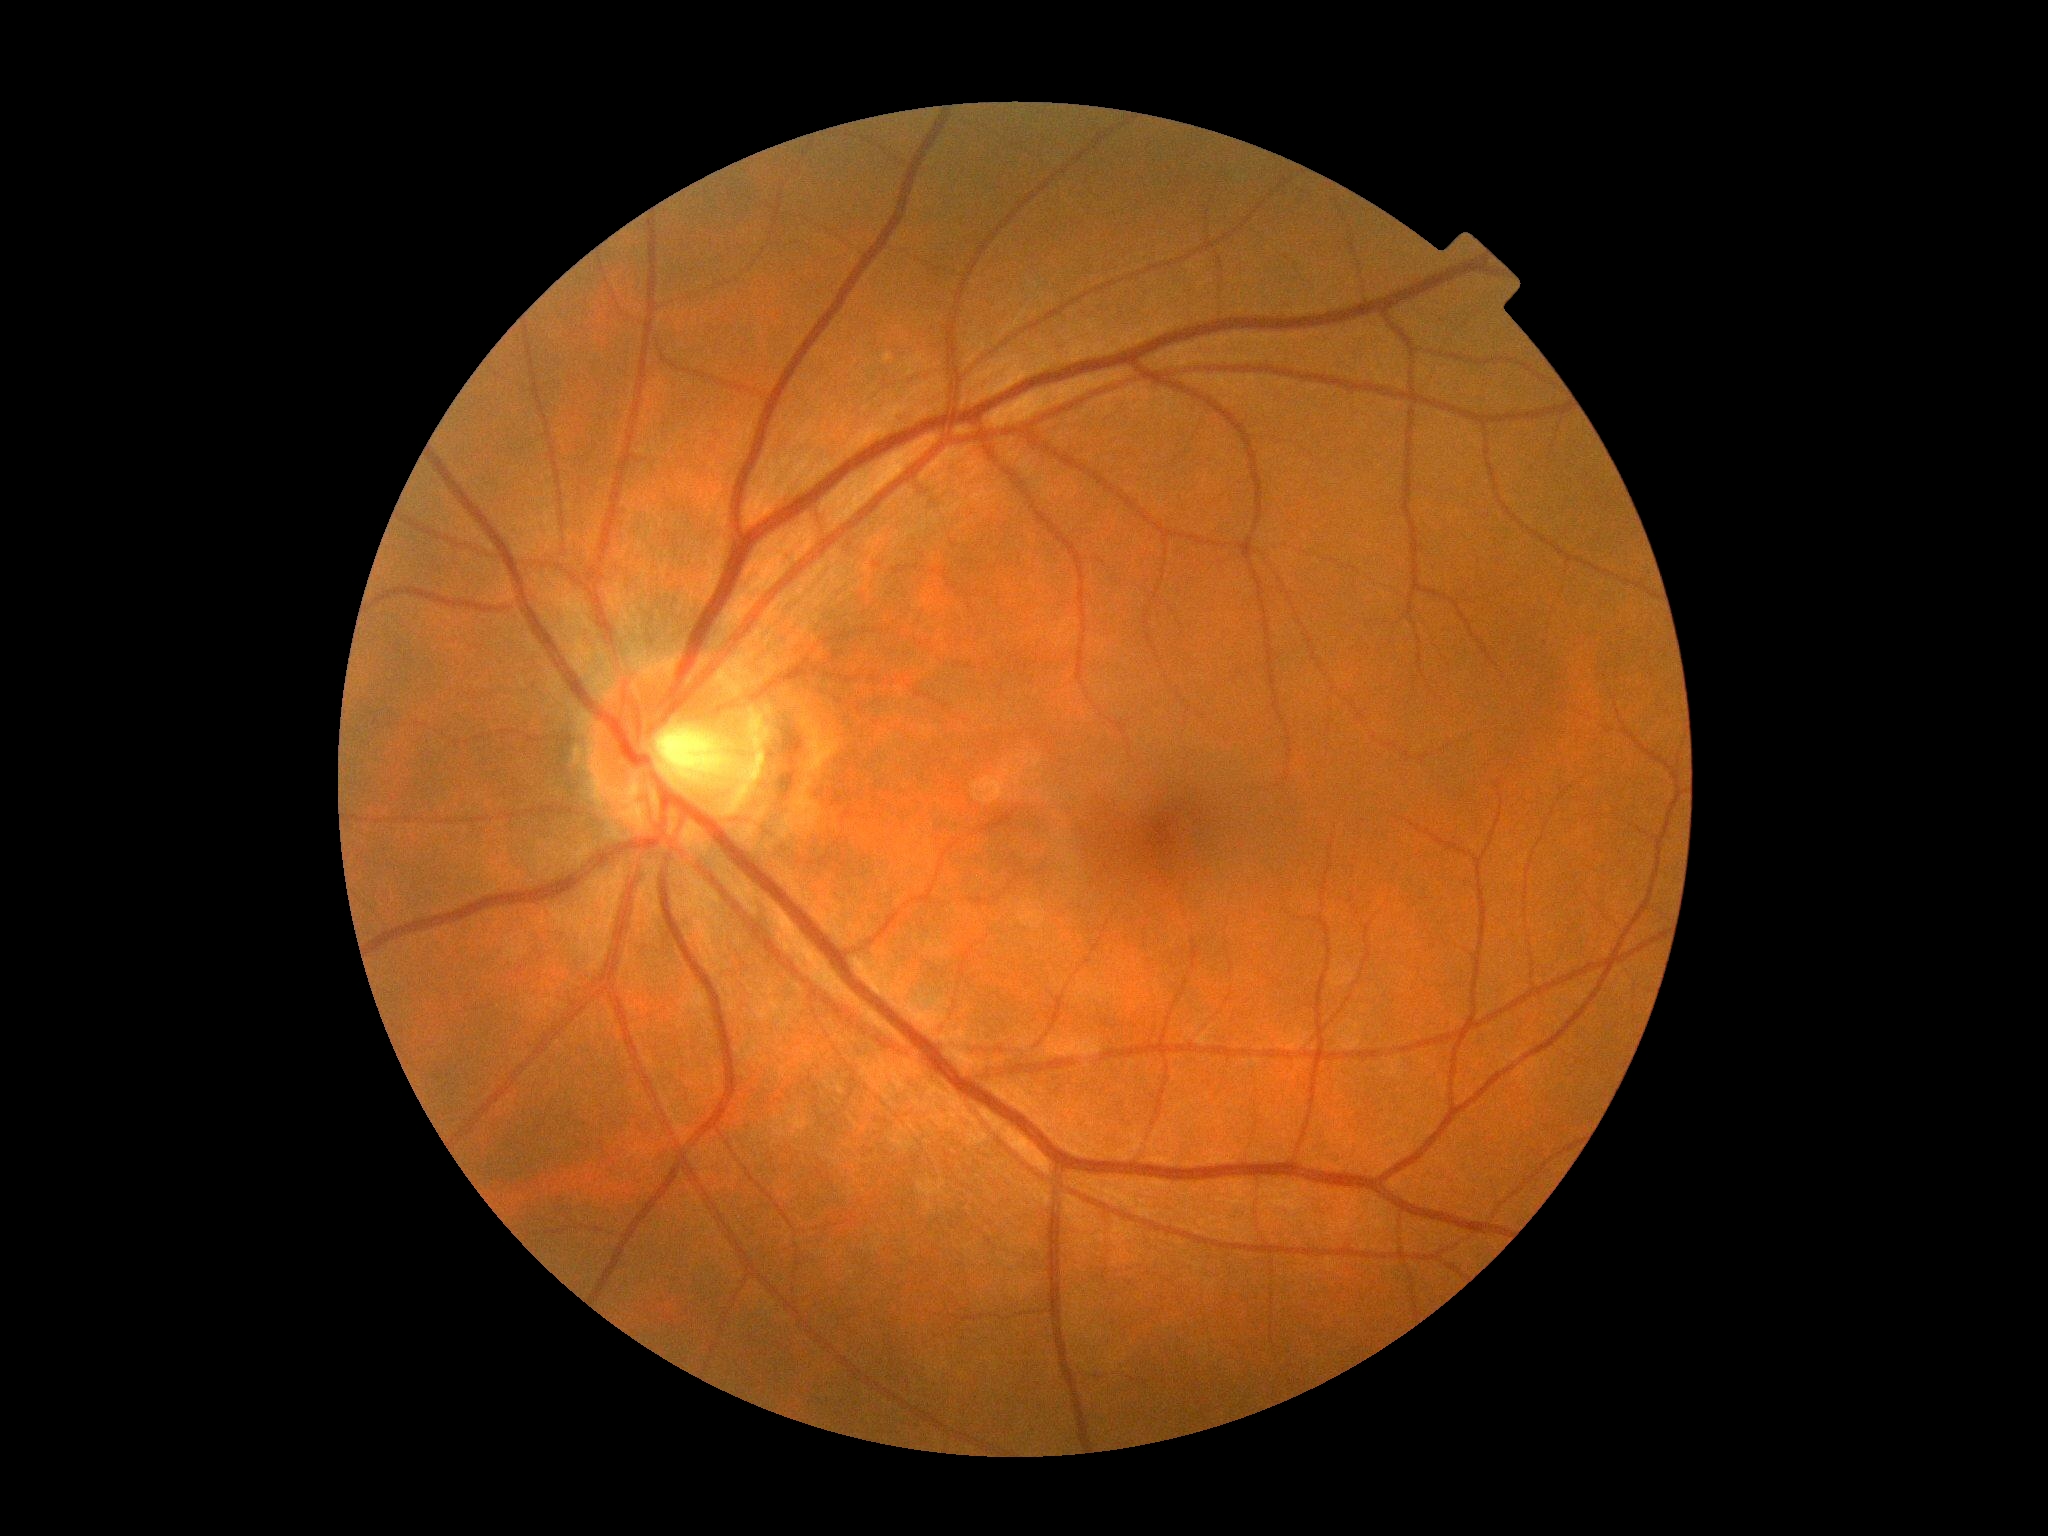
{"dr_grade": "grade 0 (no apparent retinopathy) — no visible signs of diabetic retinopathy"}